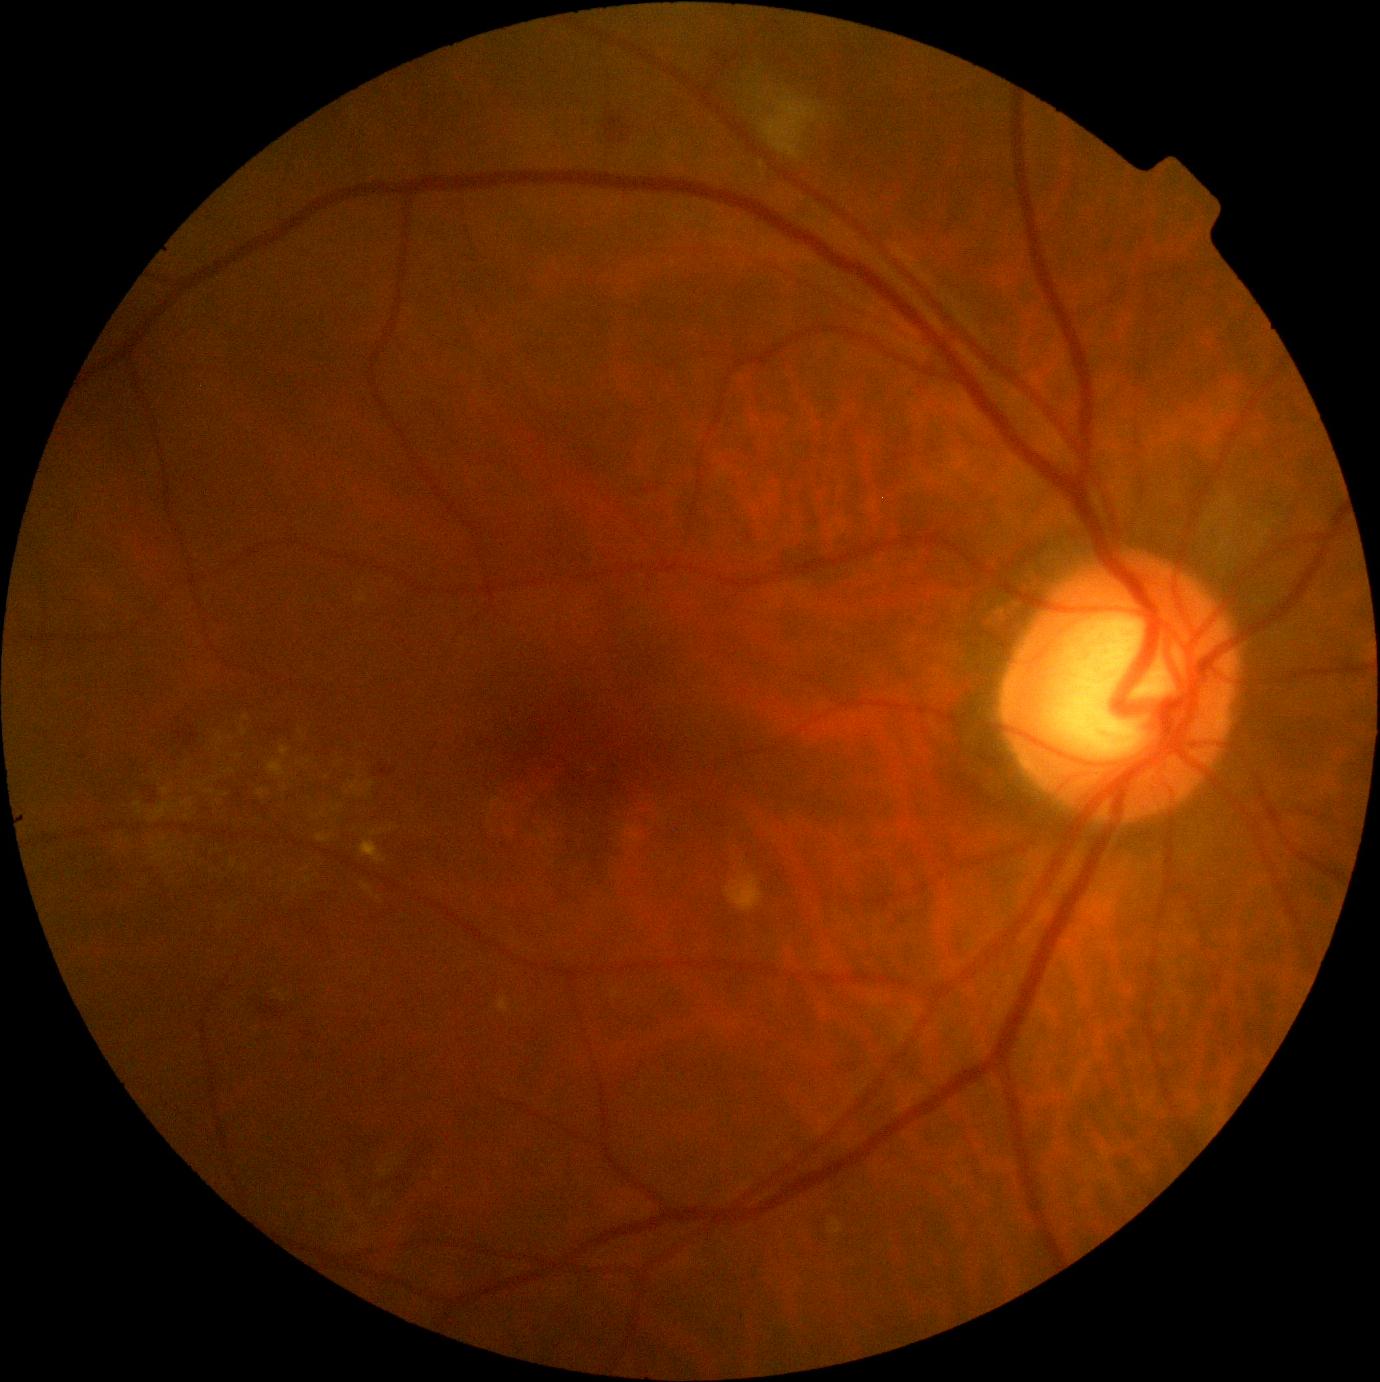 Diabetic retinopathy severity: moderate NPDR (grade 2) — more than just microaneurysms but less than severe NPDR.